FOV: 45 degrees:
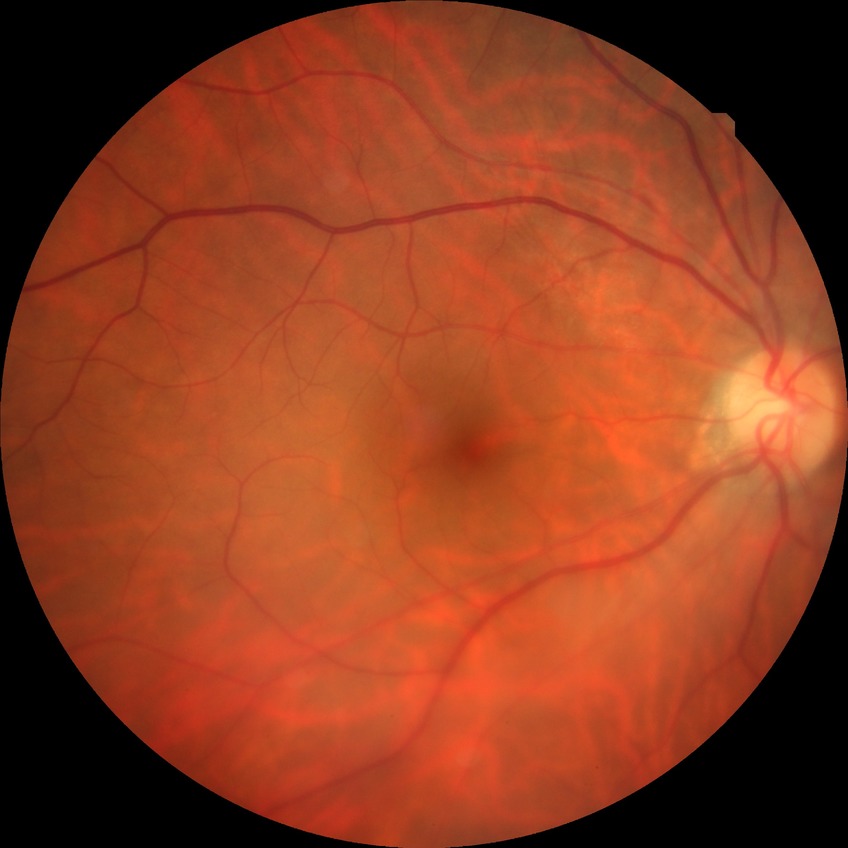 No signs of diabetic retinopathy. DR is NDR.